Color fundus photograph: 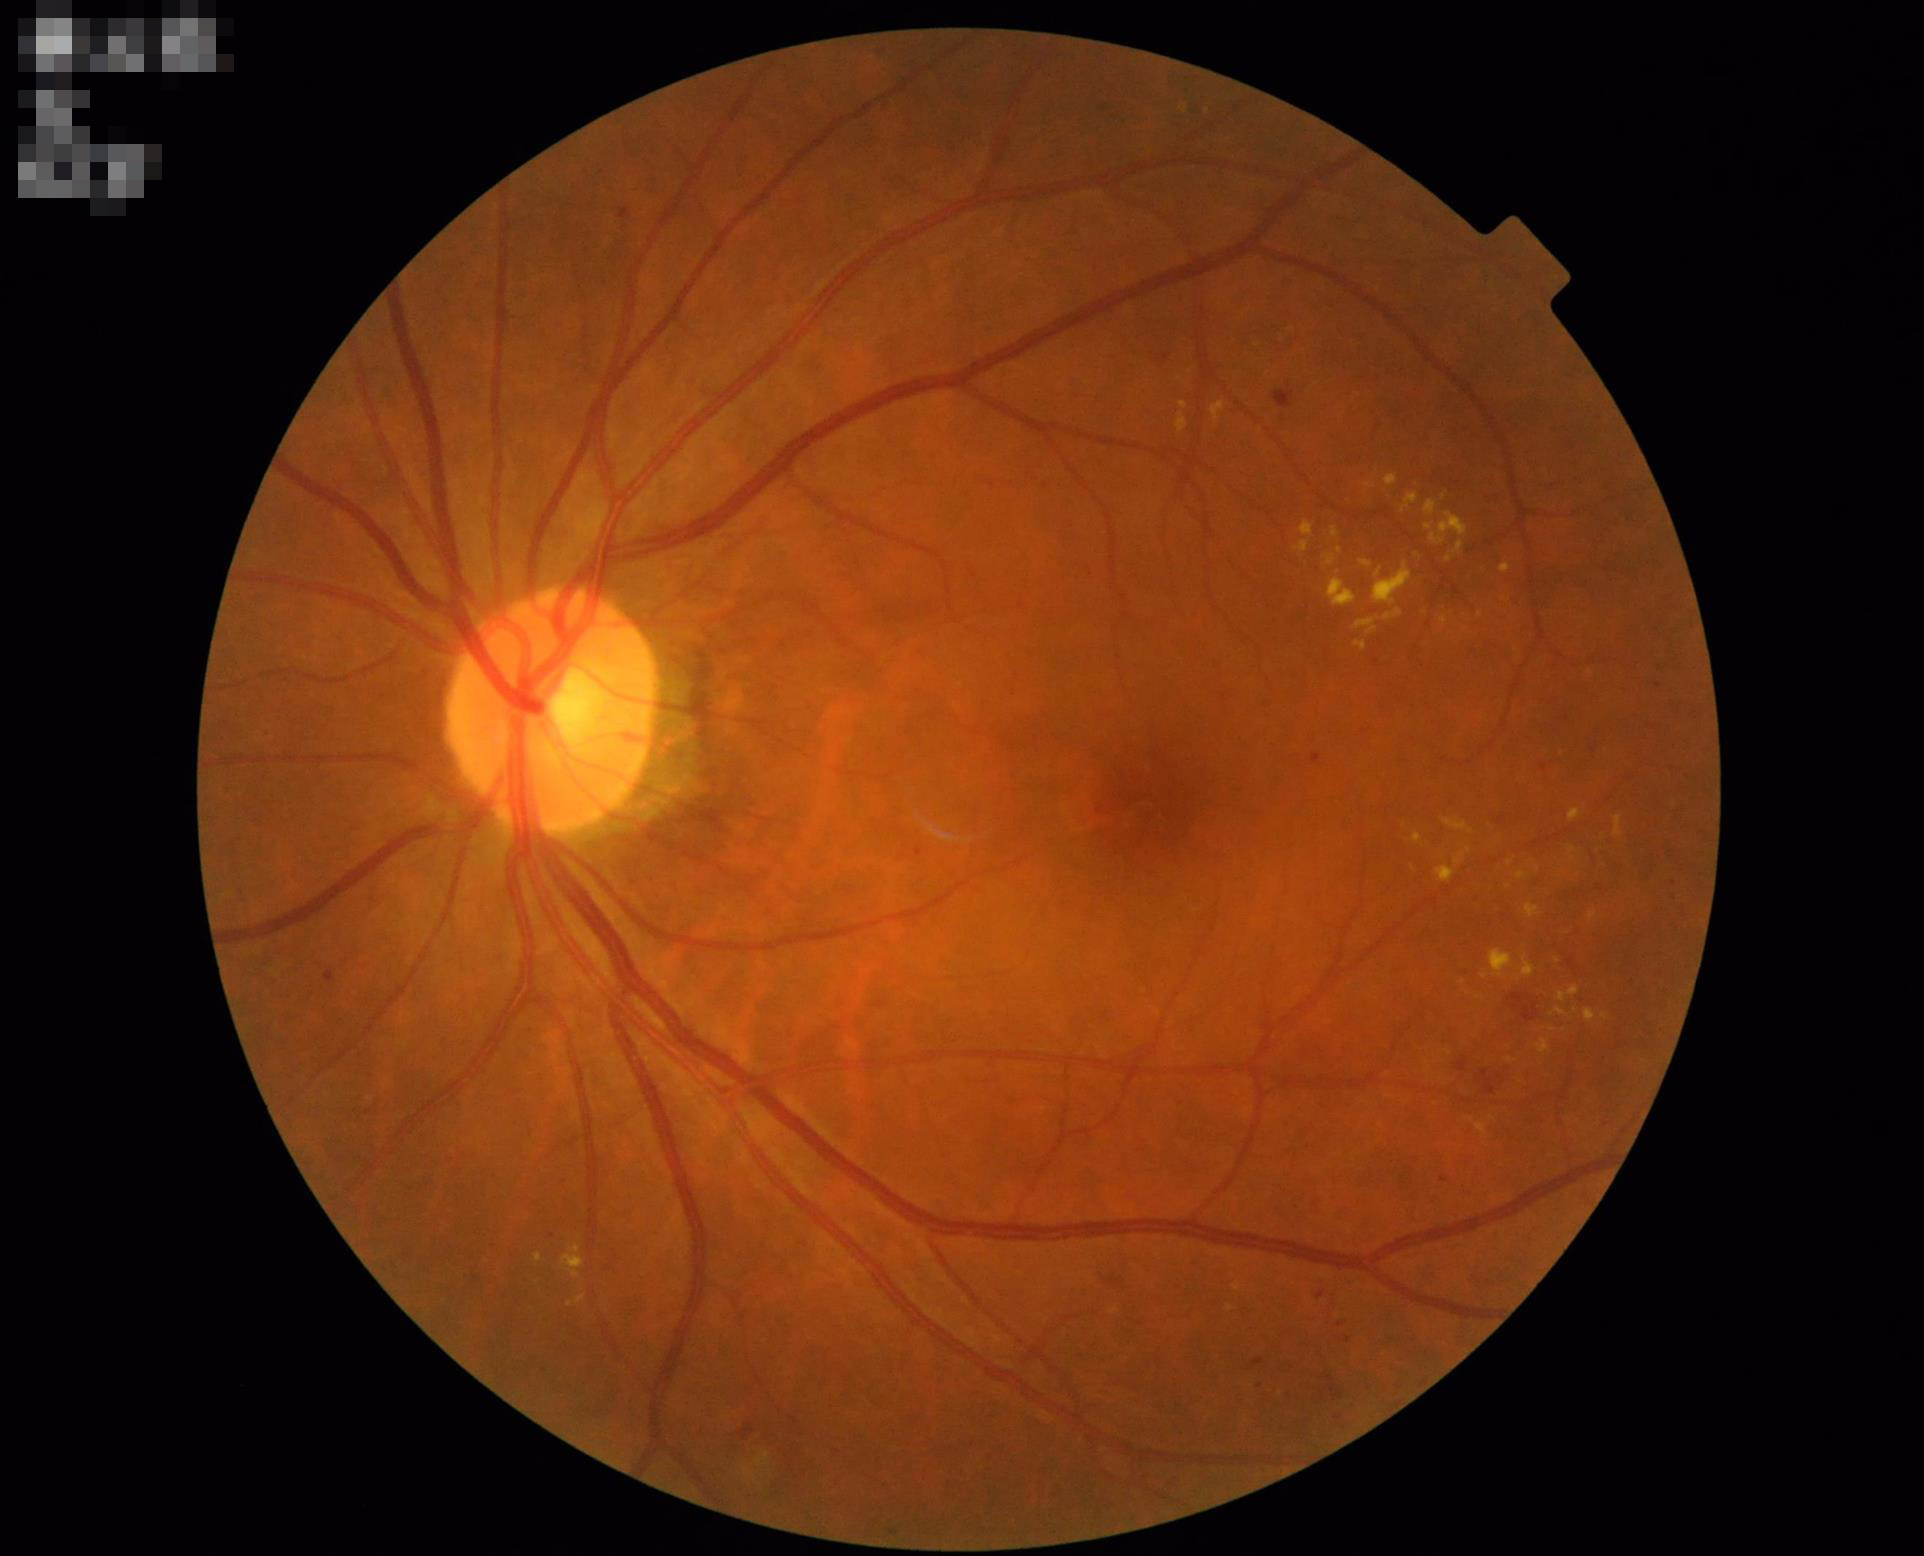 Quality grading:
- sharpness: sharp throughout the field
- illumination/color: no over- or under-exposure
- overall: adequate for clinical interpretation
- contrast: wide intensity range, structures distinguishable